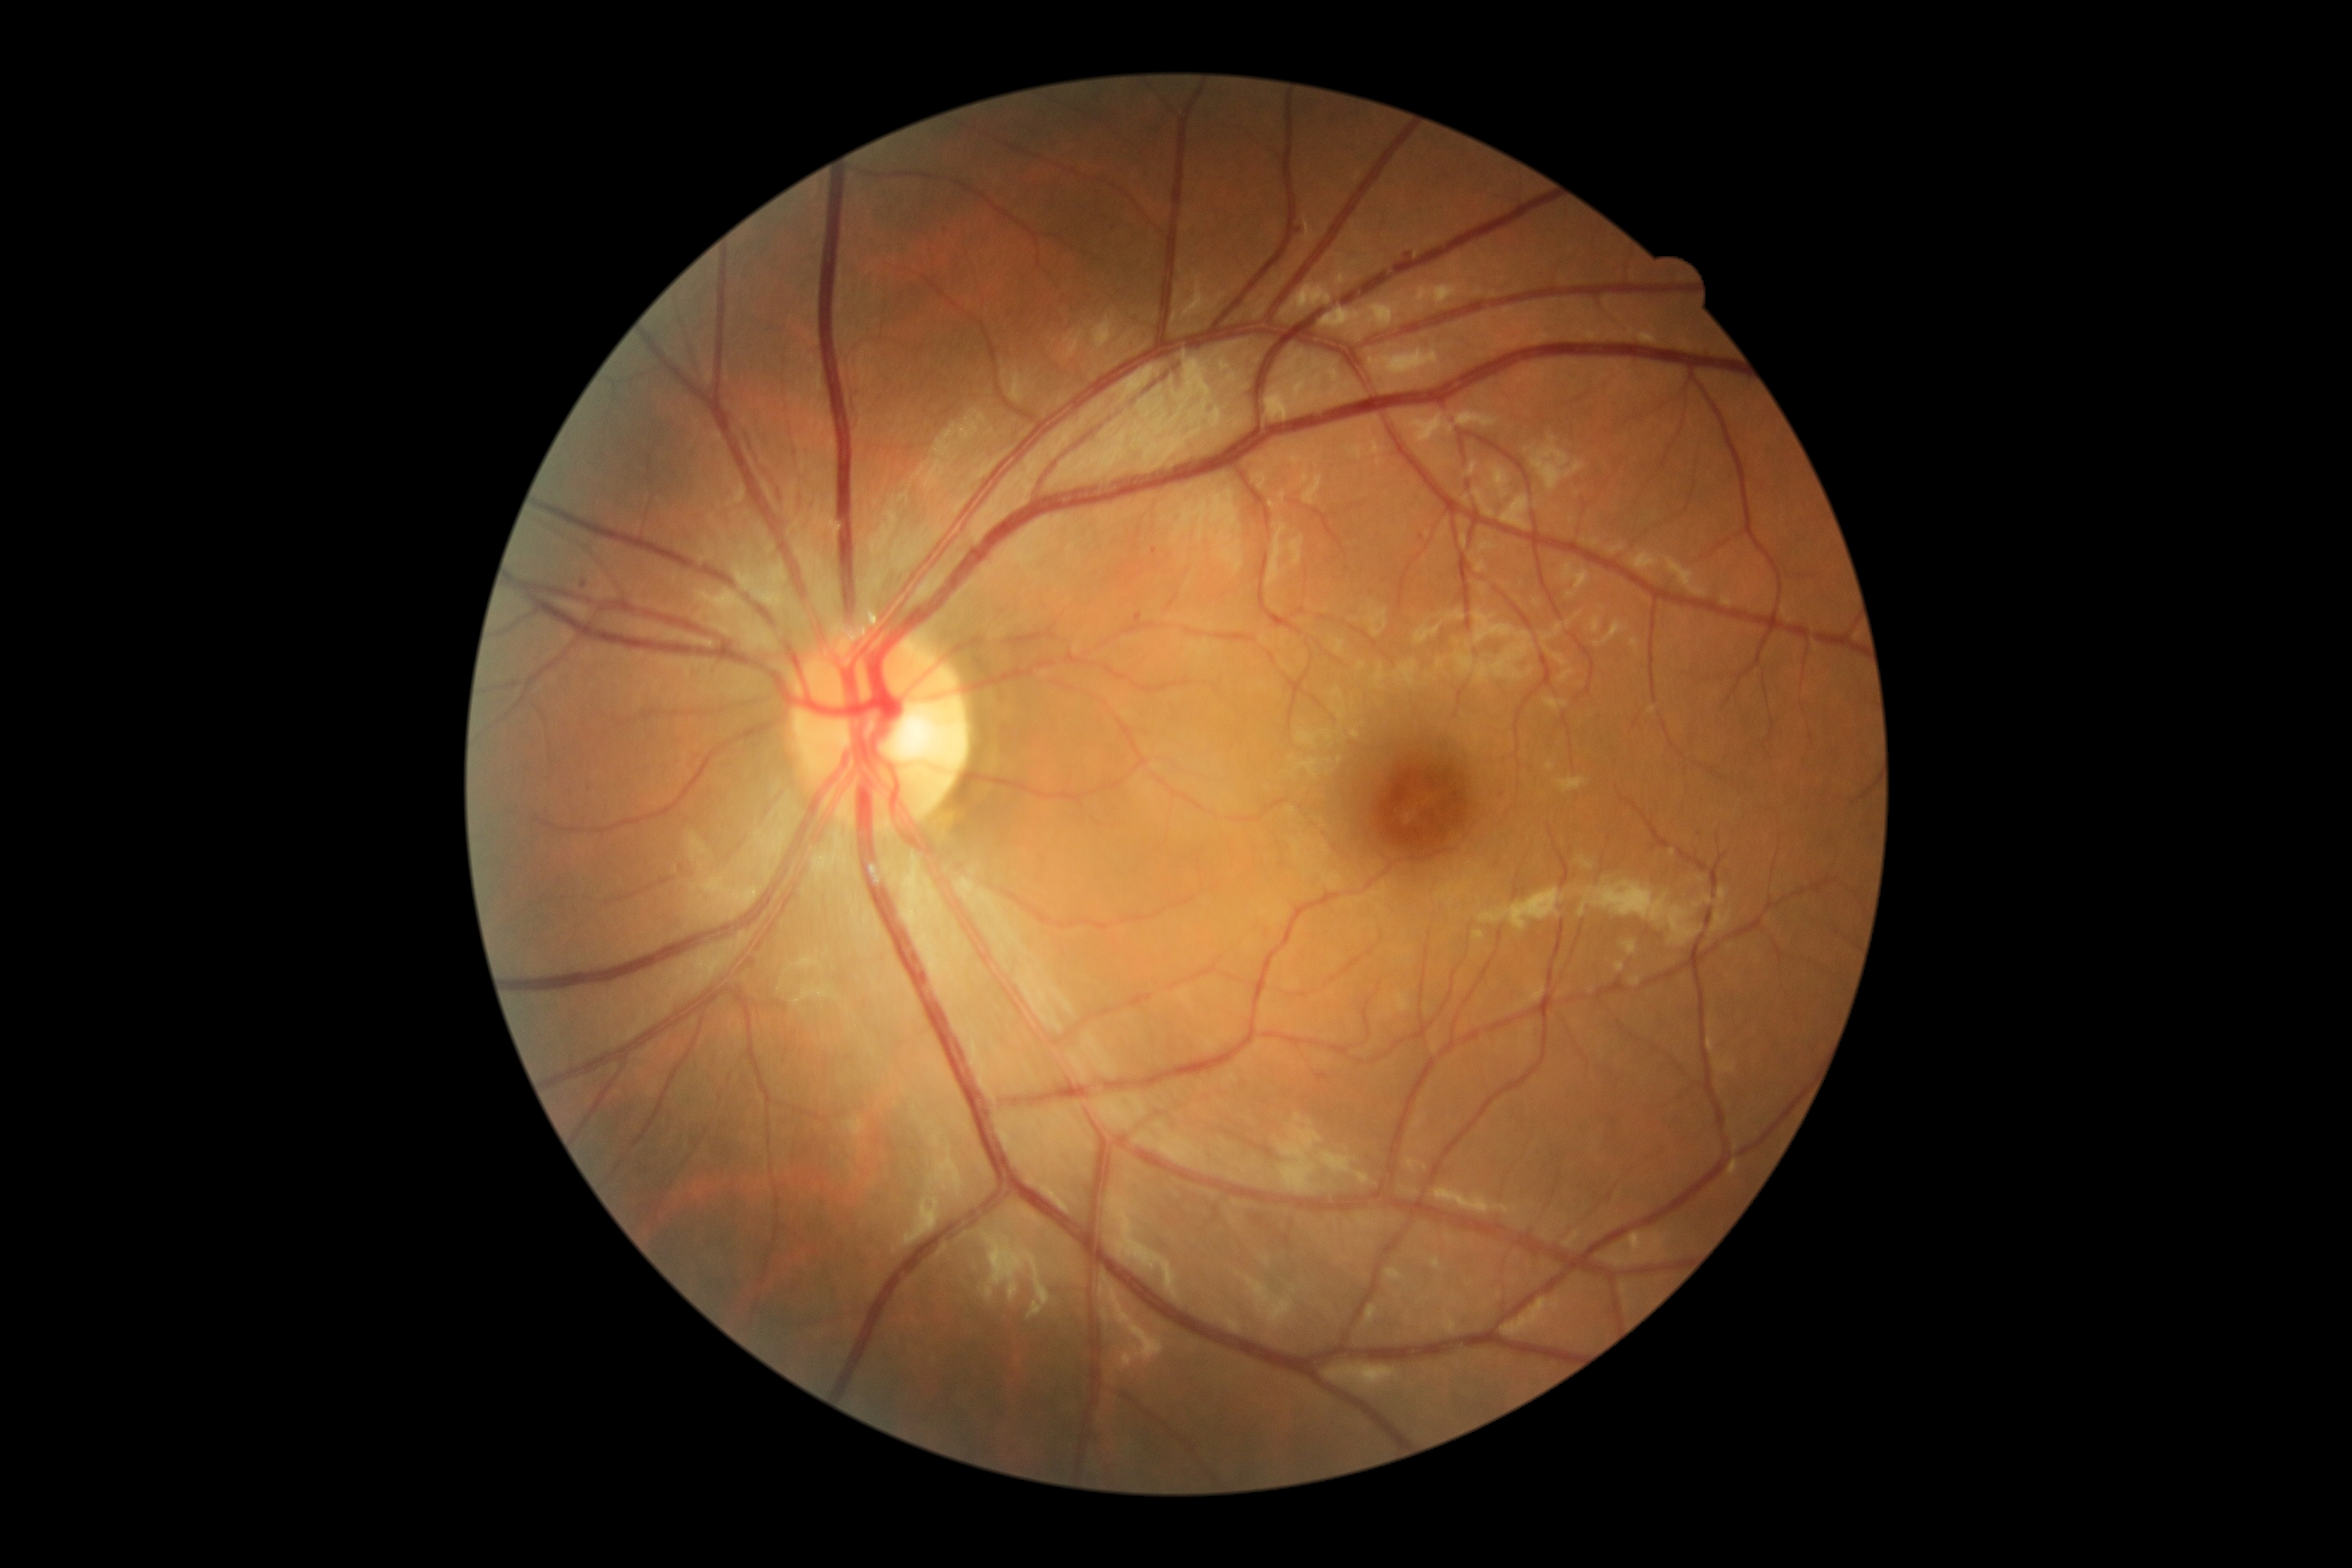
Retinopathy is mild non-proliferative diabetic retinopathy (grade 1).